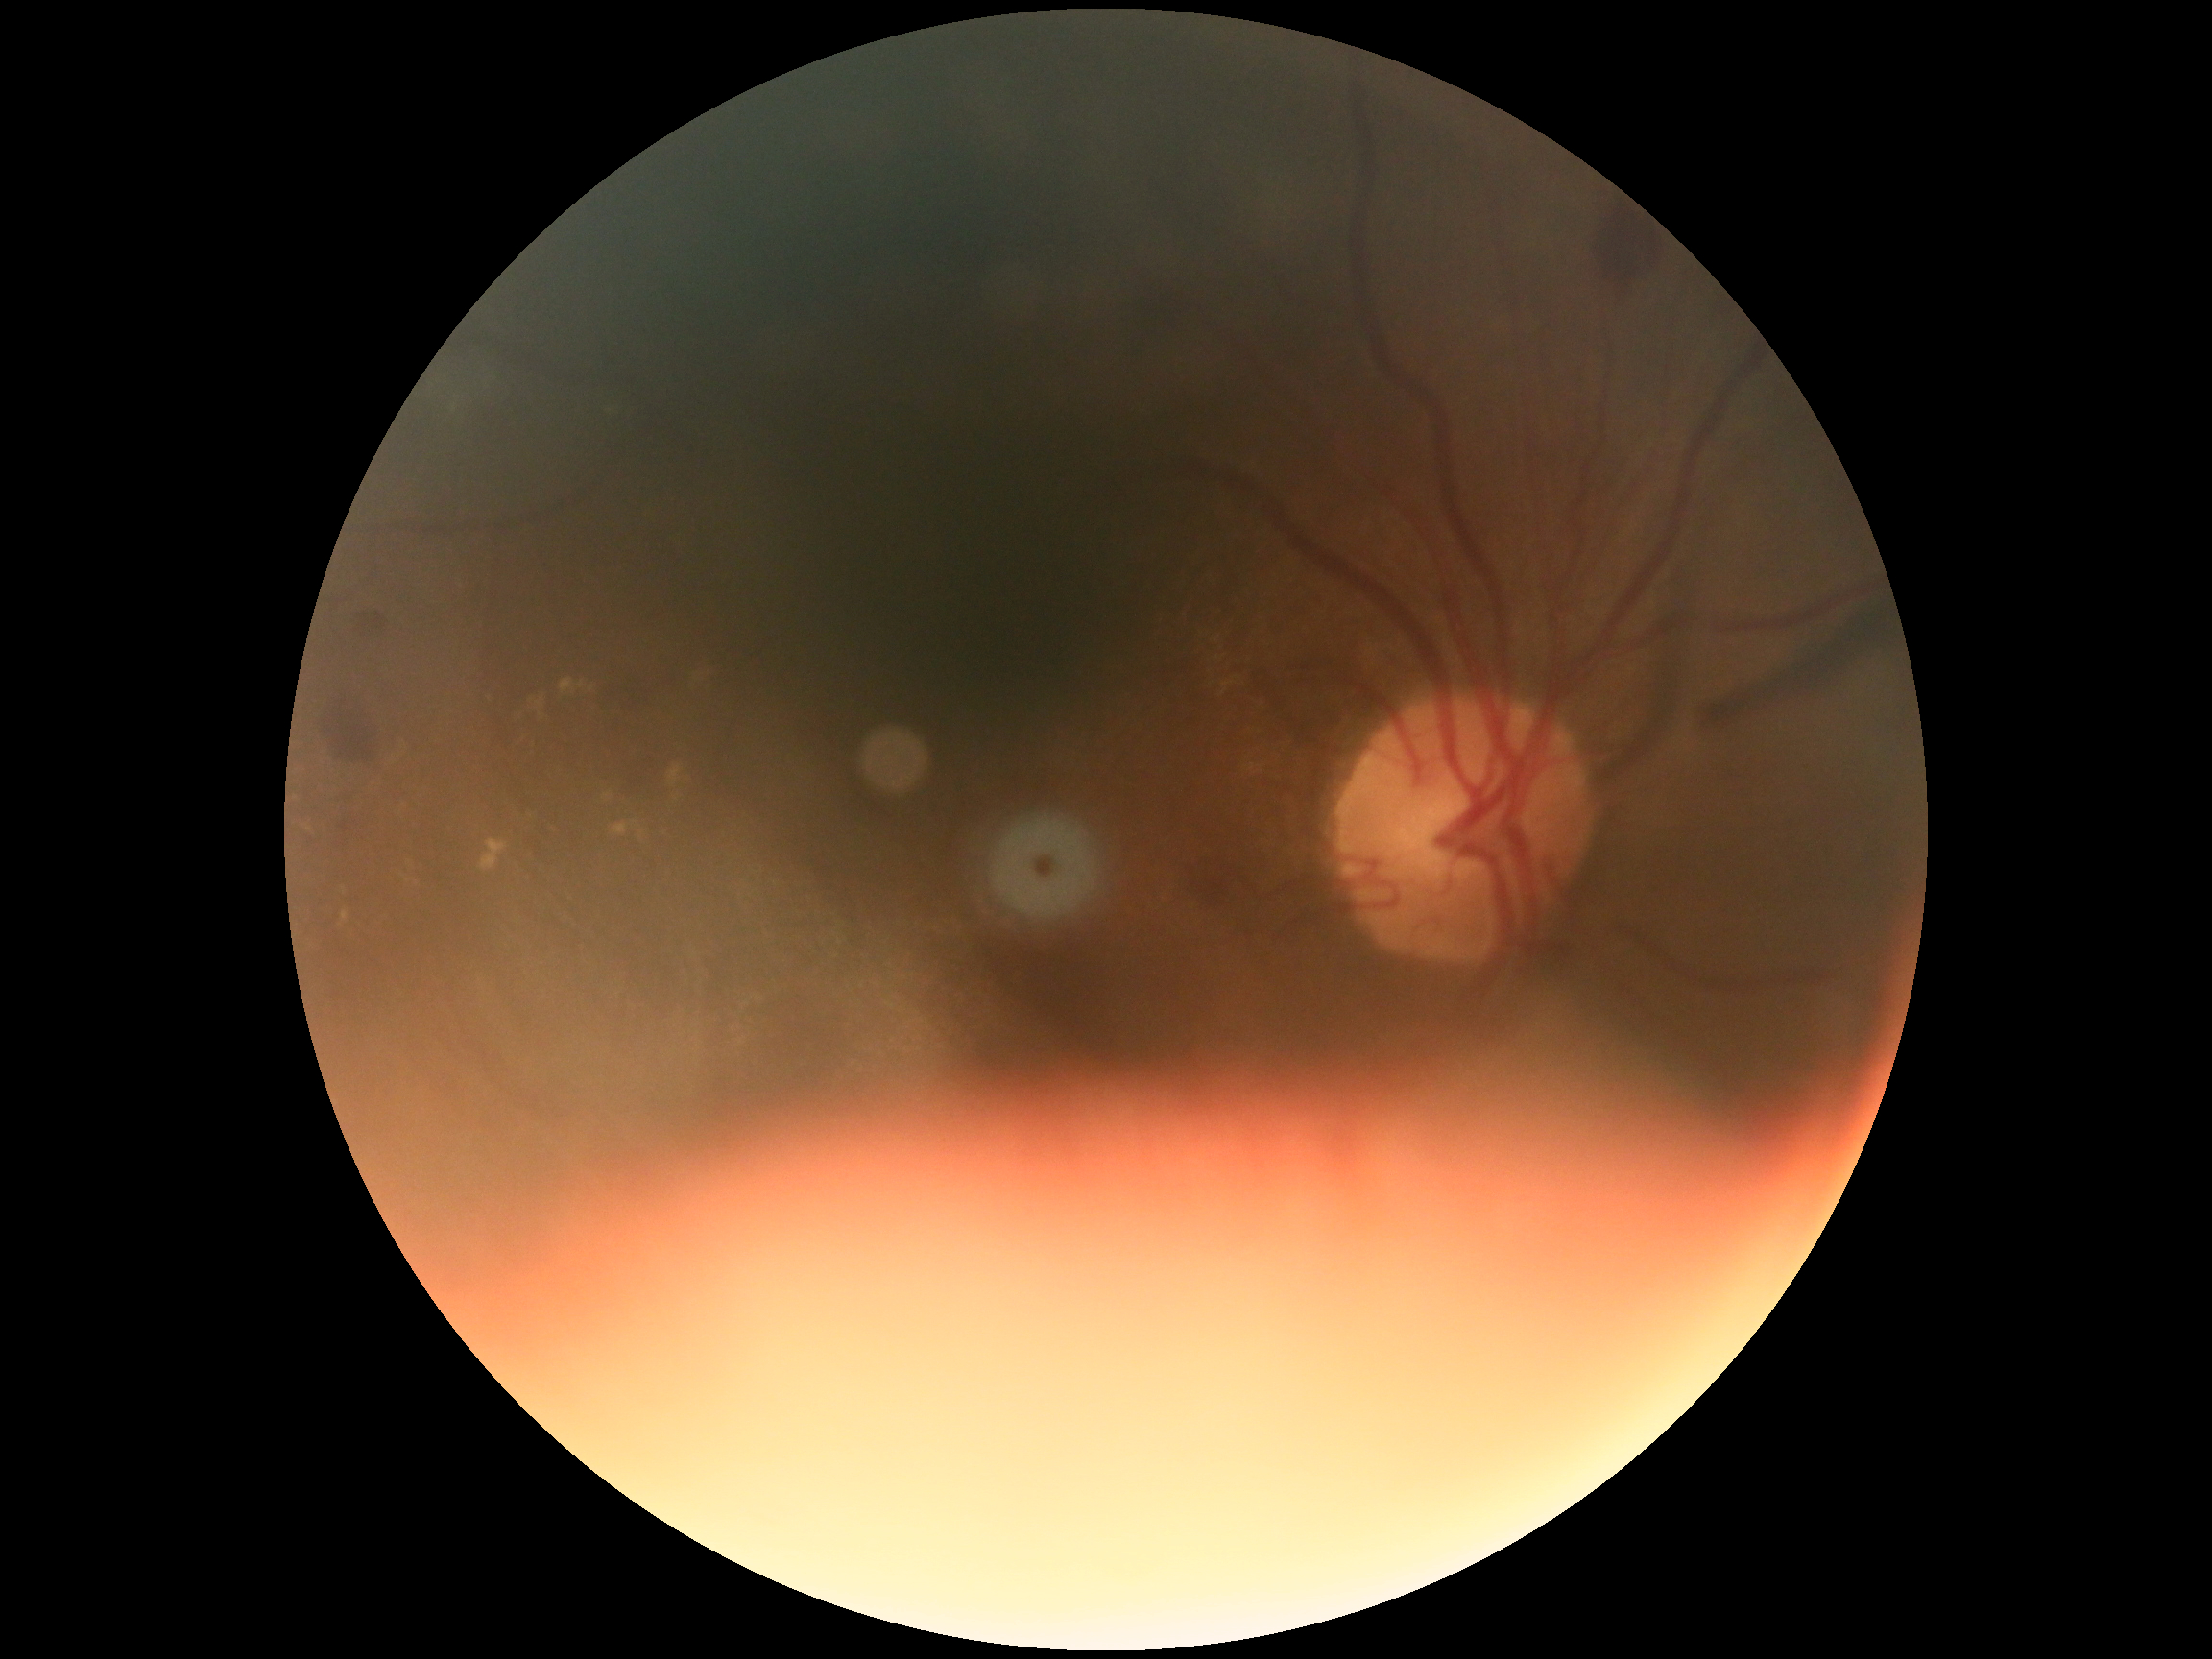
diabetic retinopathy (DR): moderate NPDR (grade 2).